Acquired with a NIDEK AFC-230: 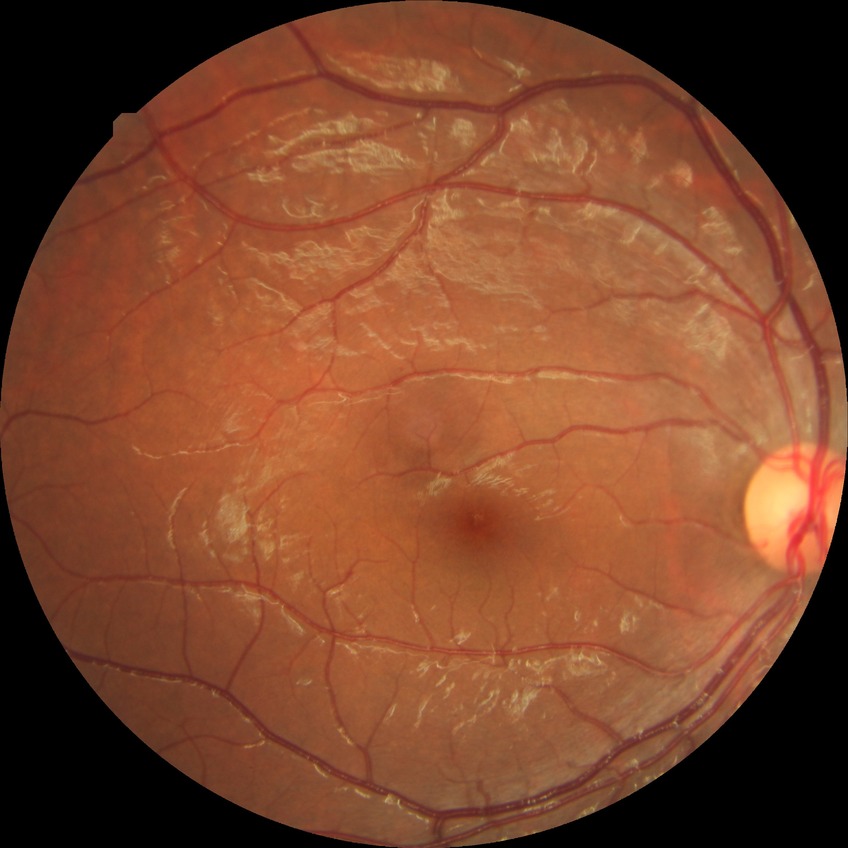

Diabetic retinopathy (DR) is simple diabetic retinopathy (SDR).